Modified Davis grading — 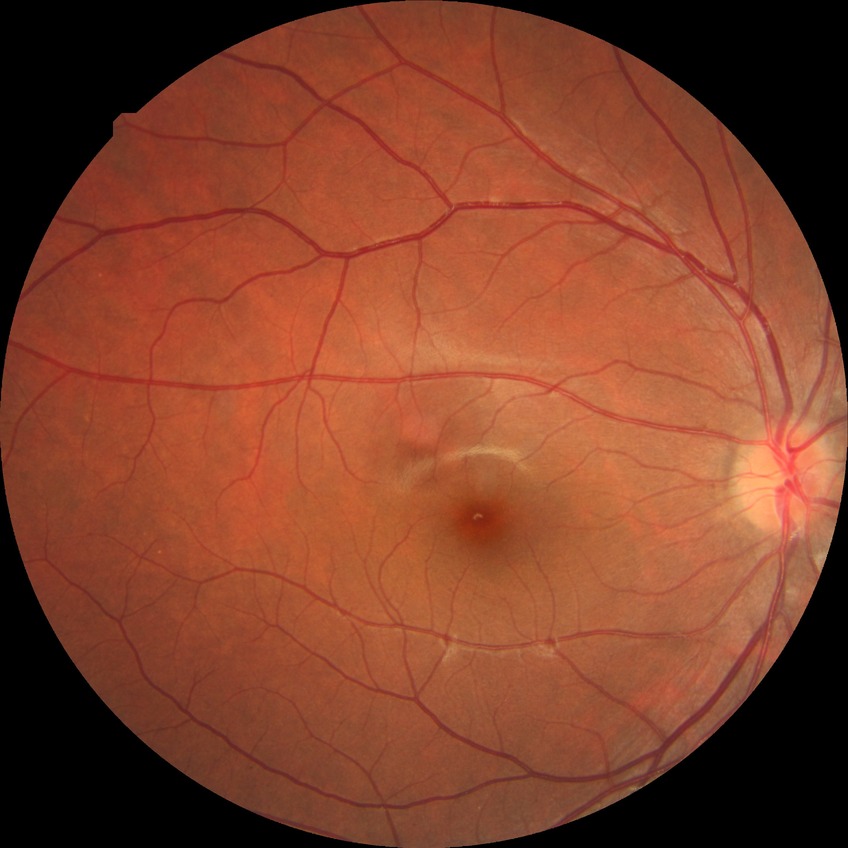 modified Davis grade: NDR.